Camera: NIDEK AFC-230:
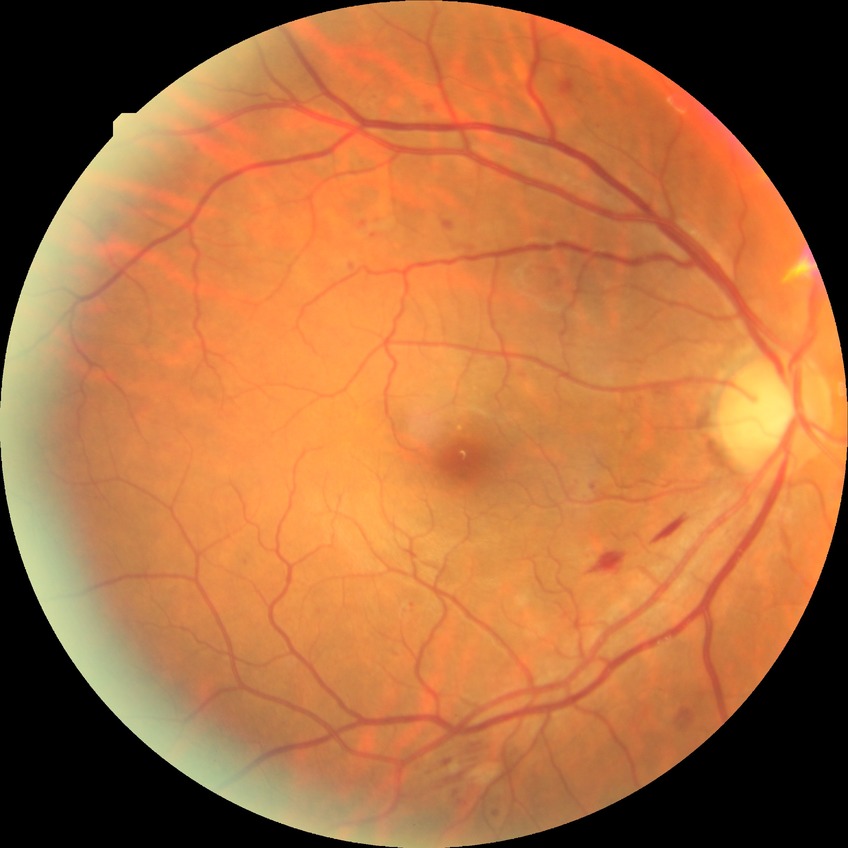
  davis_grade: PPDR (pre-proliferative diabetic retinopathy)